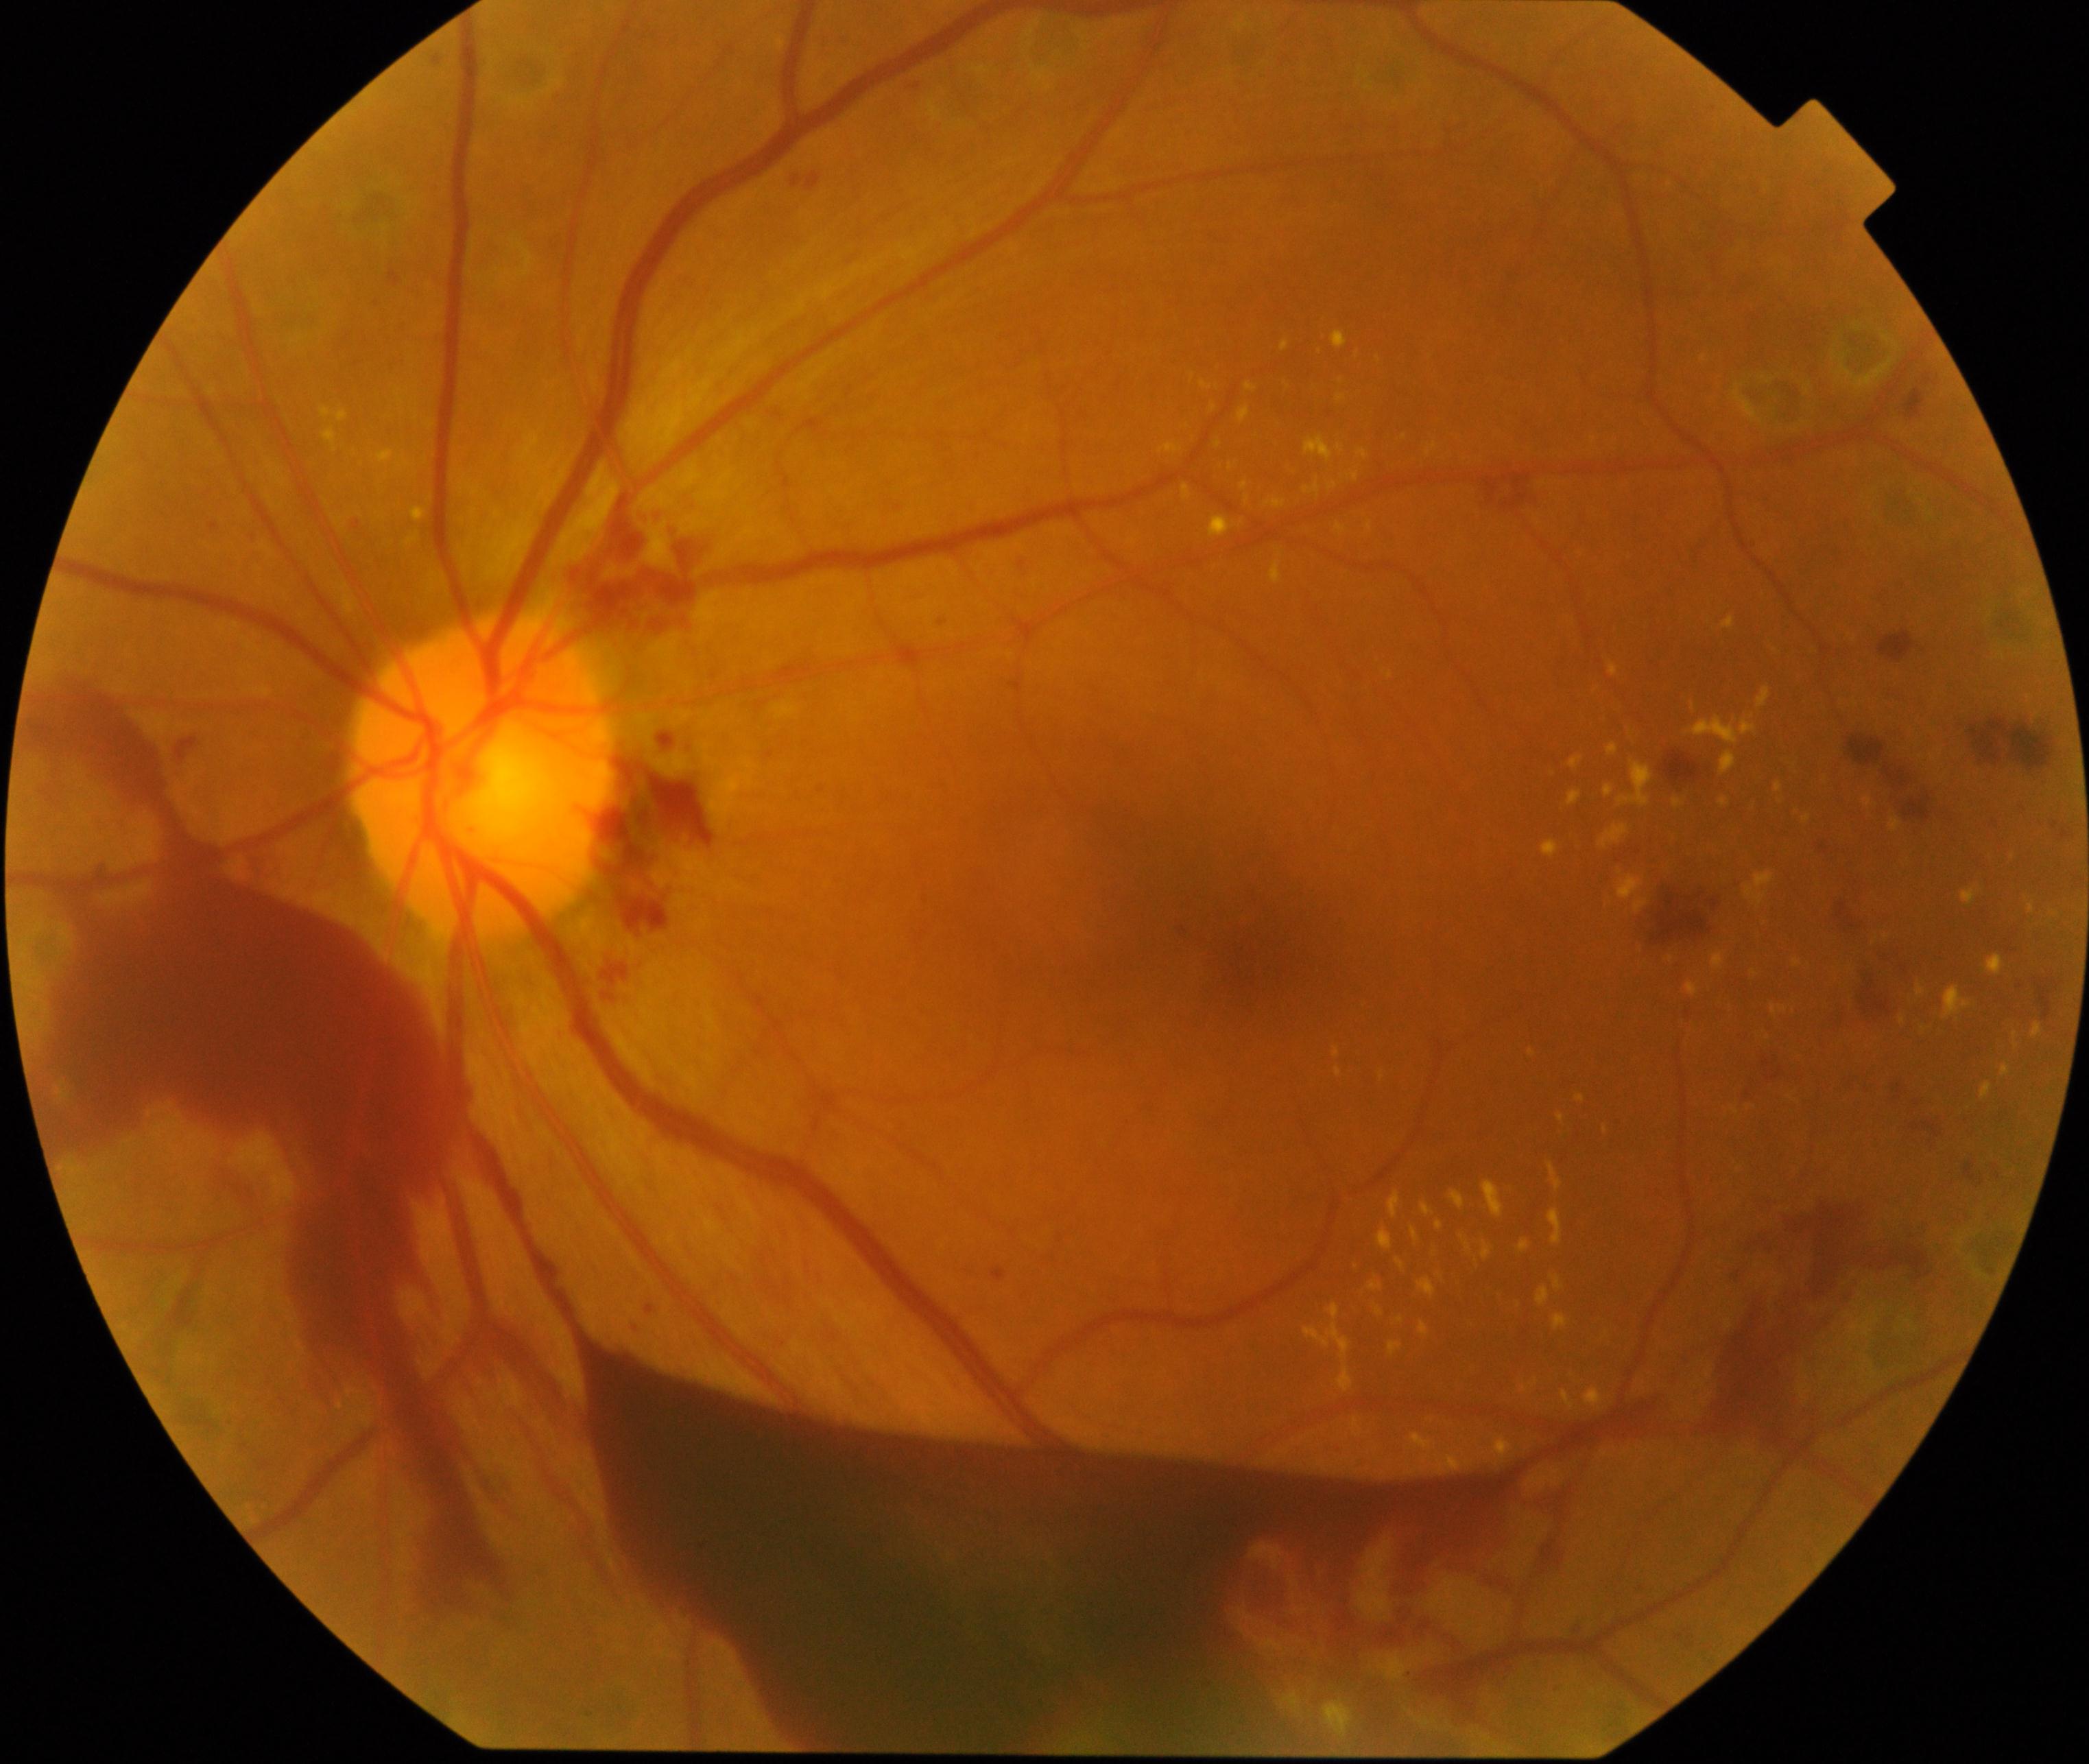

Primary finding: severe non-proliferative or proliferative diabetic retinopathy.